45 degree fundus photograph, CFP
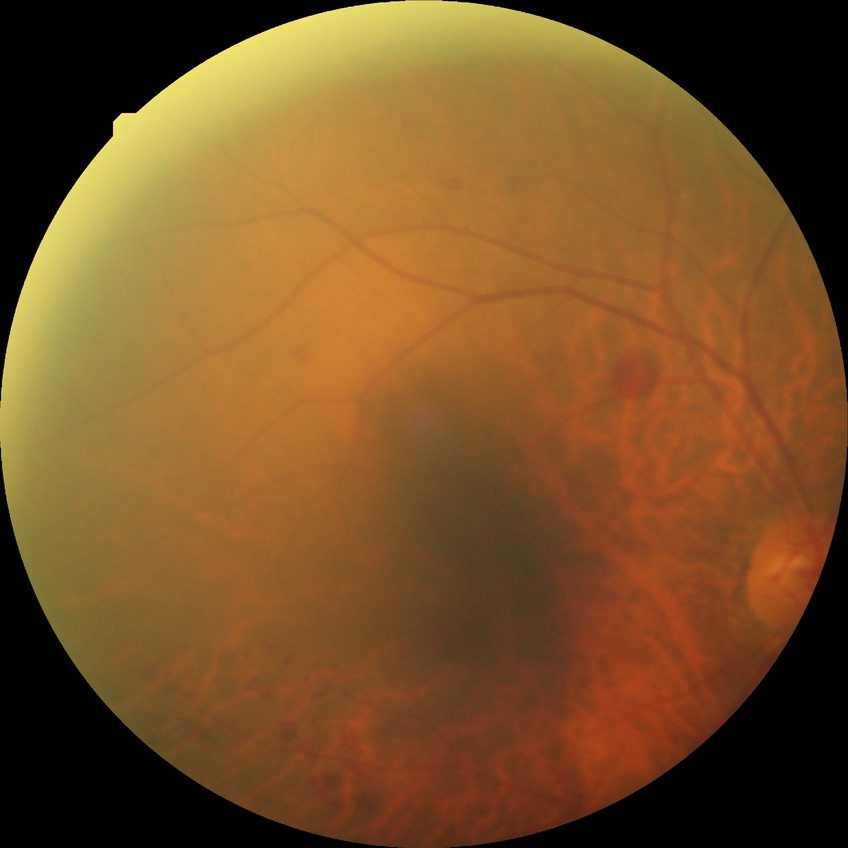 Diabetic retinopathy severity: simple diabetic retinopathy.